Color fundus photograph:
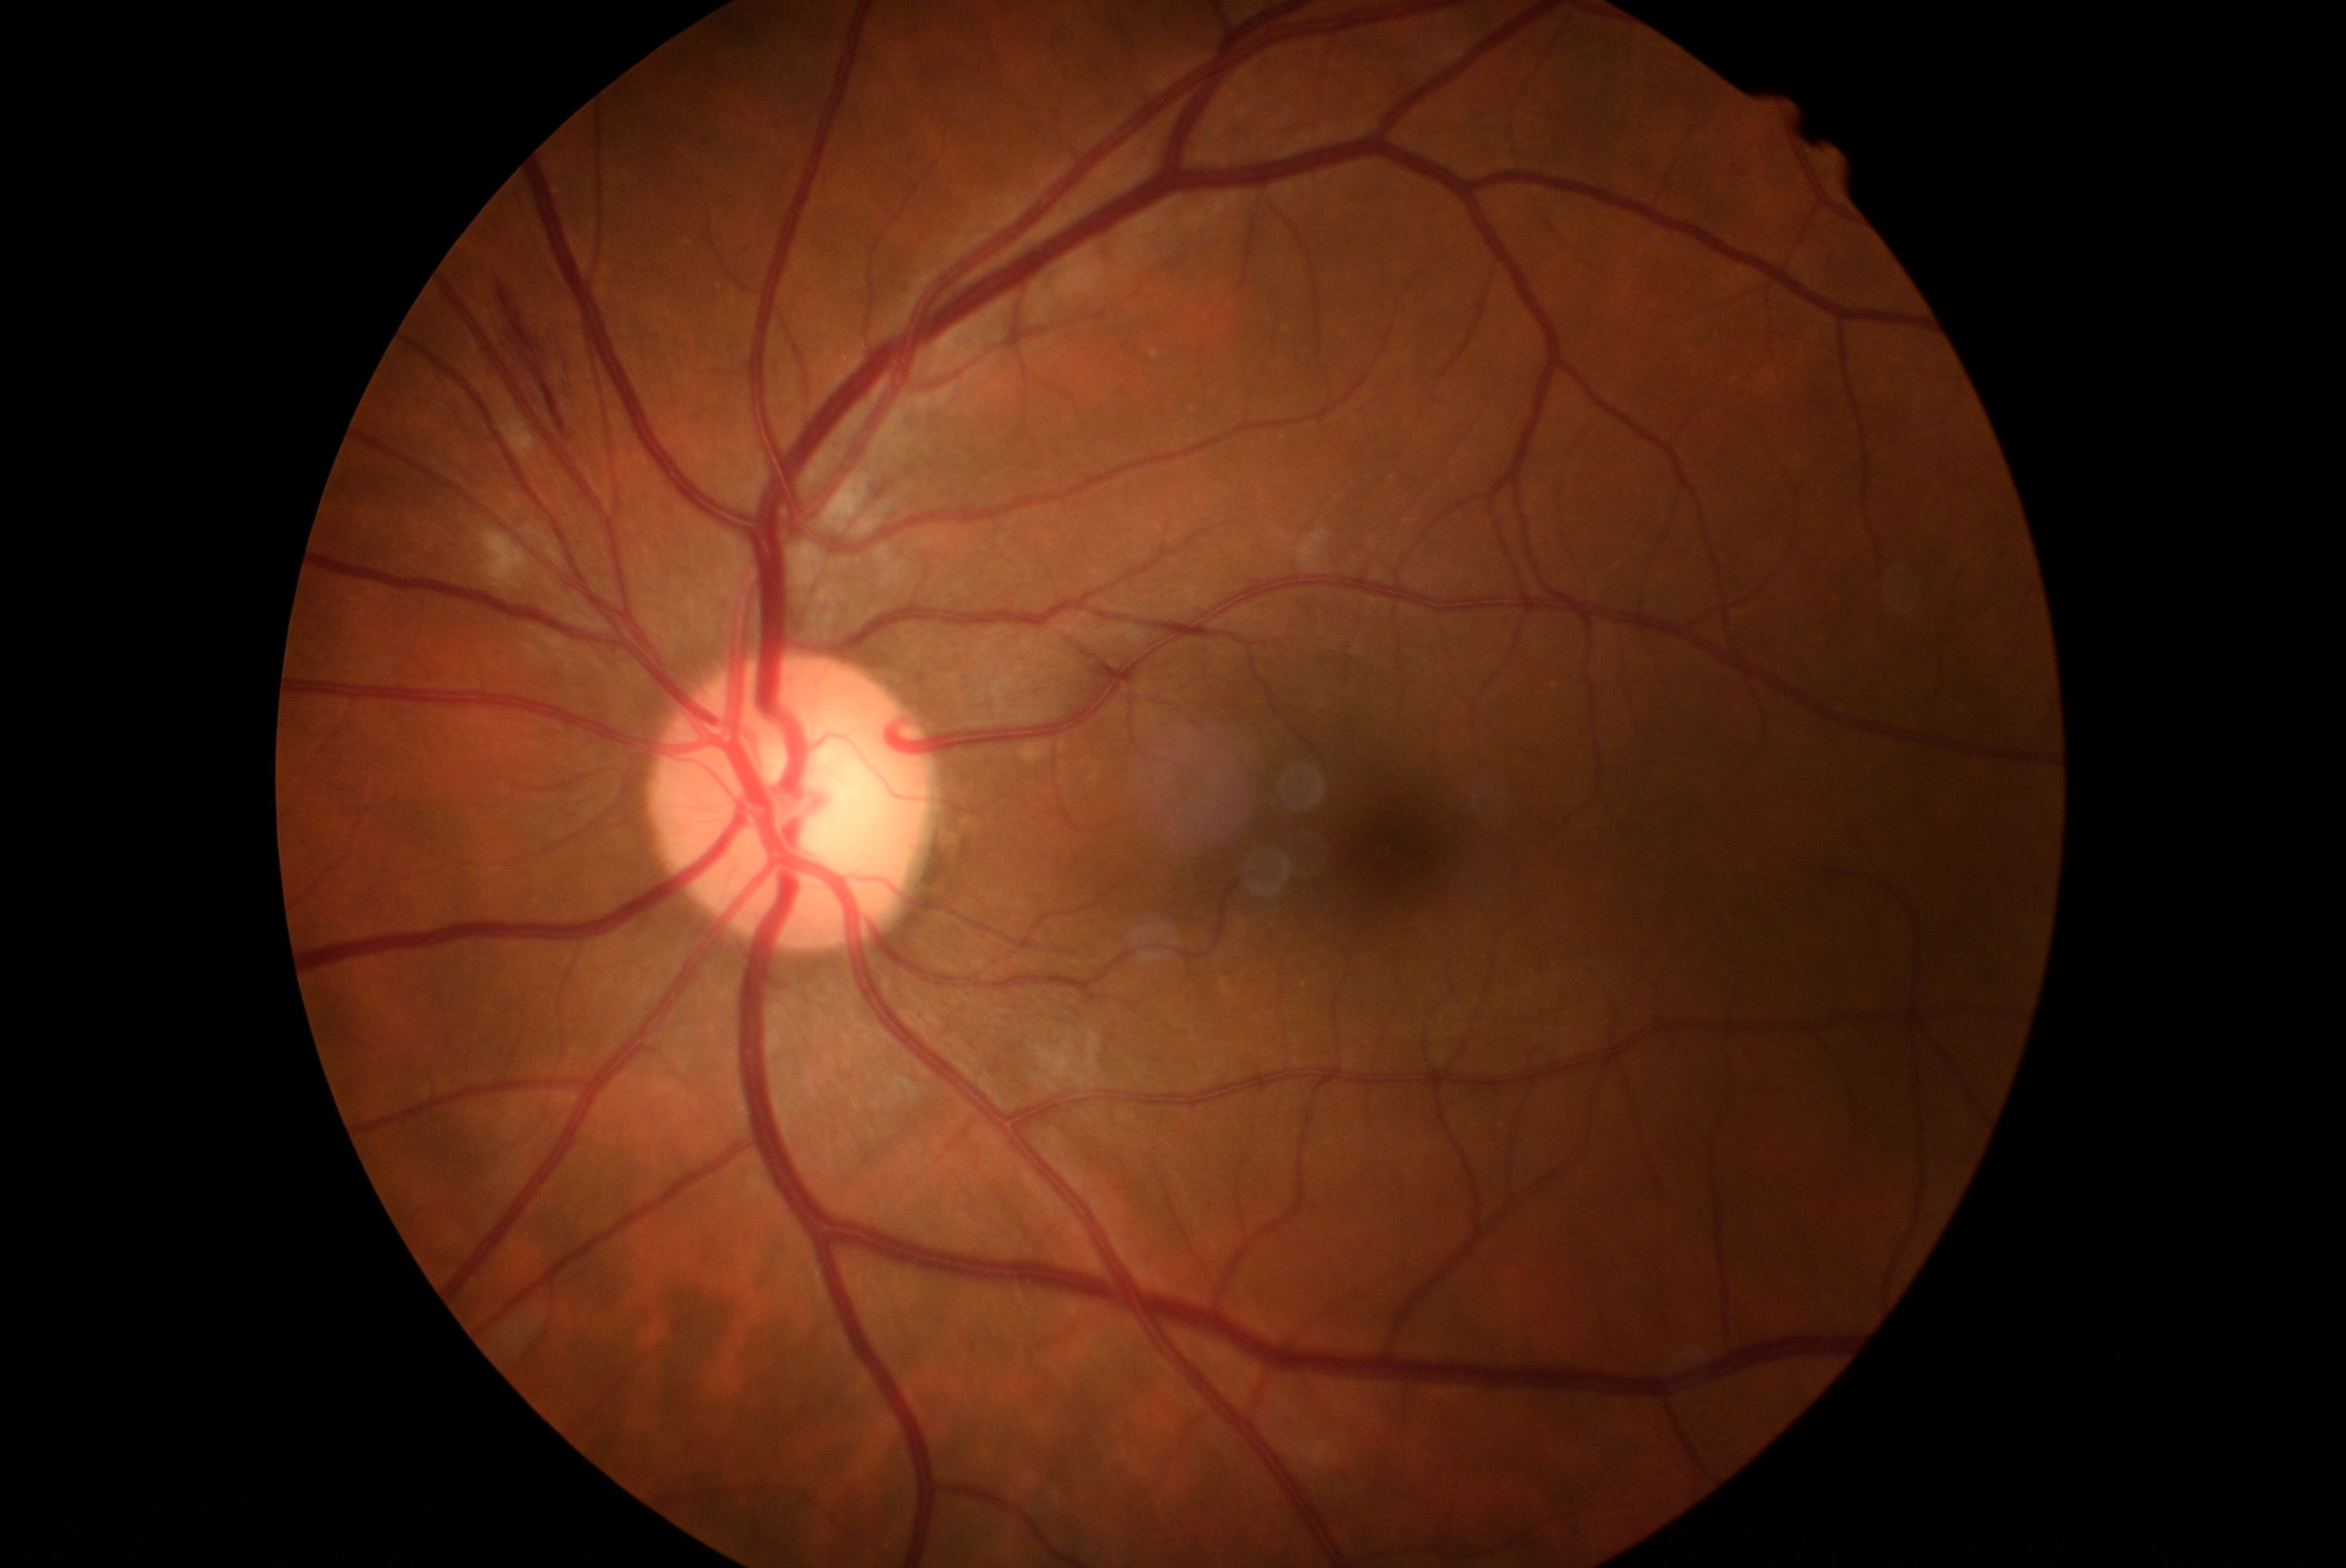 DR severity: moderate NPDR (grade 2).